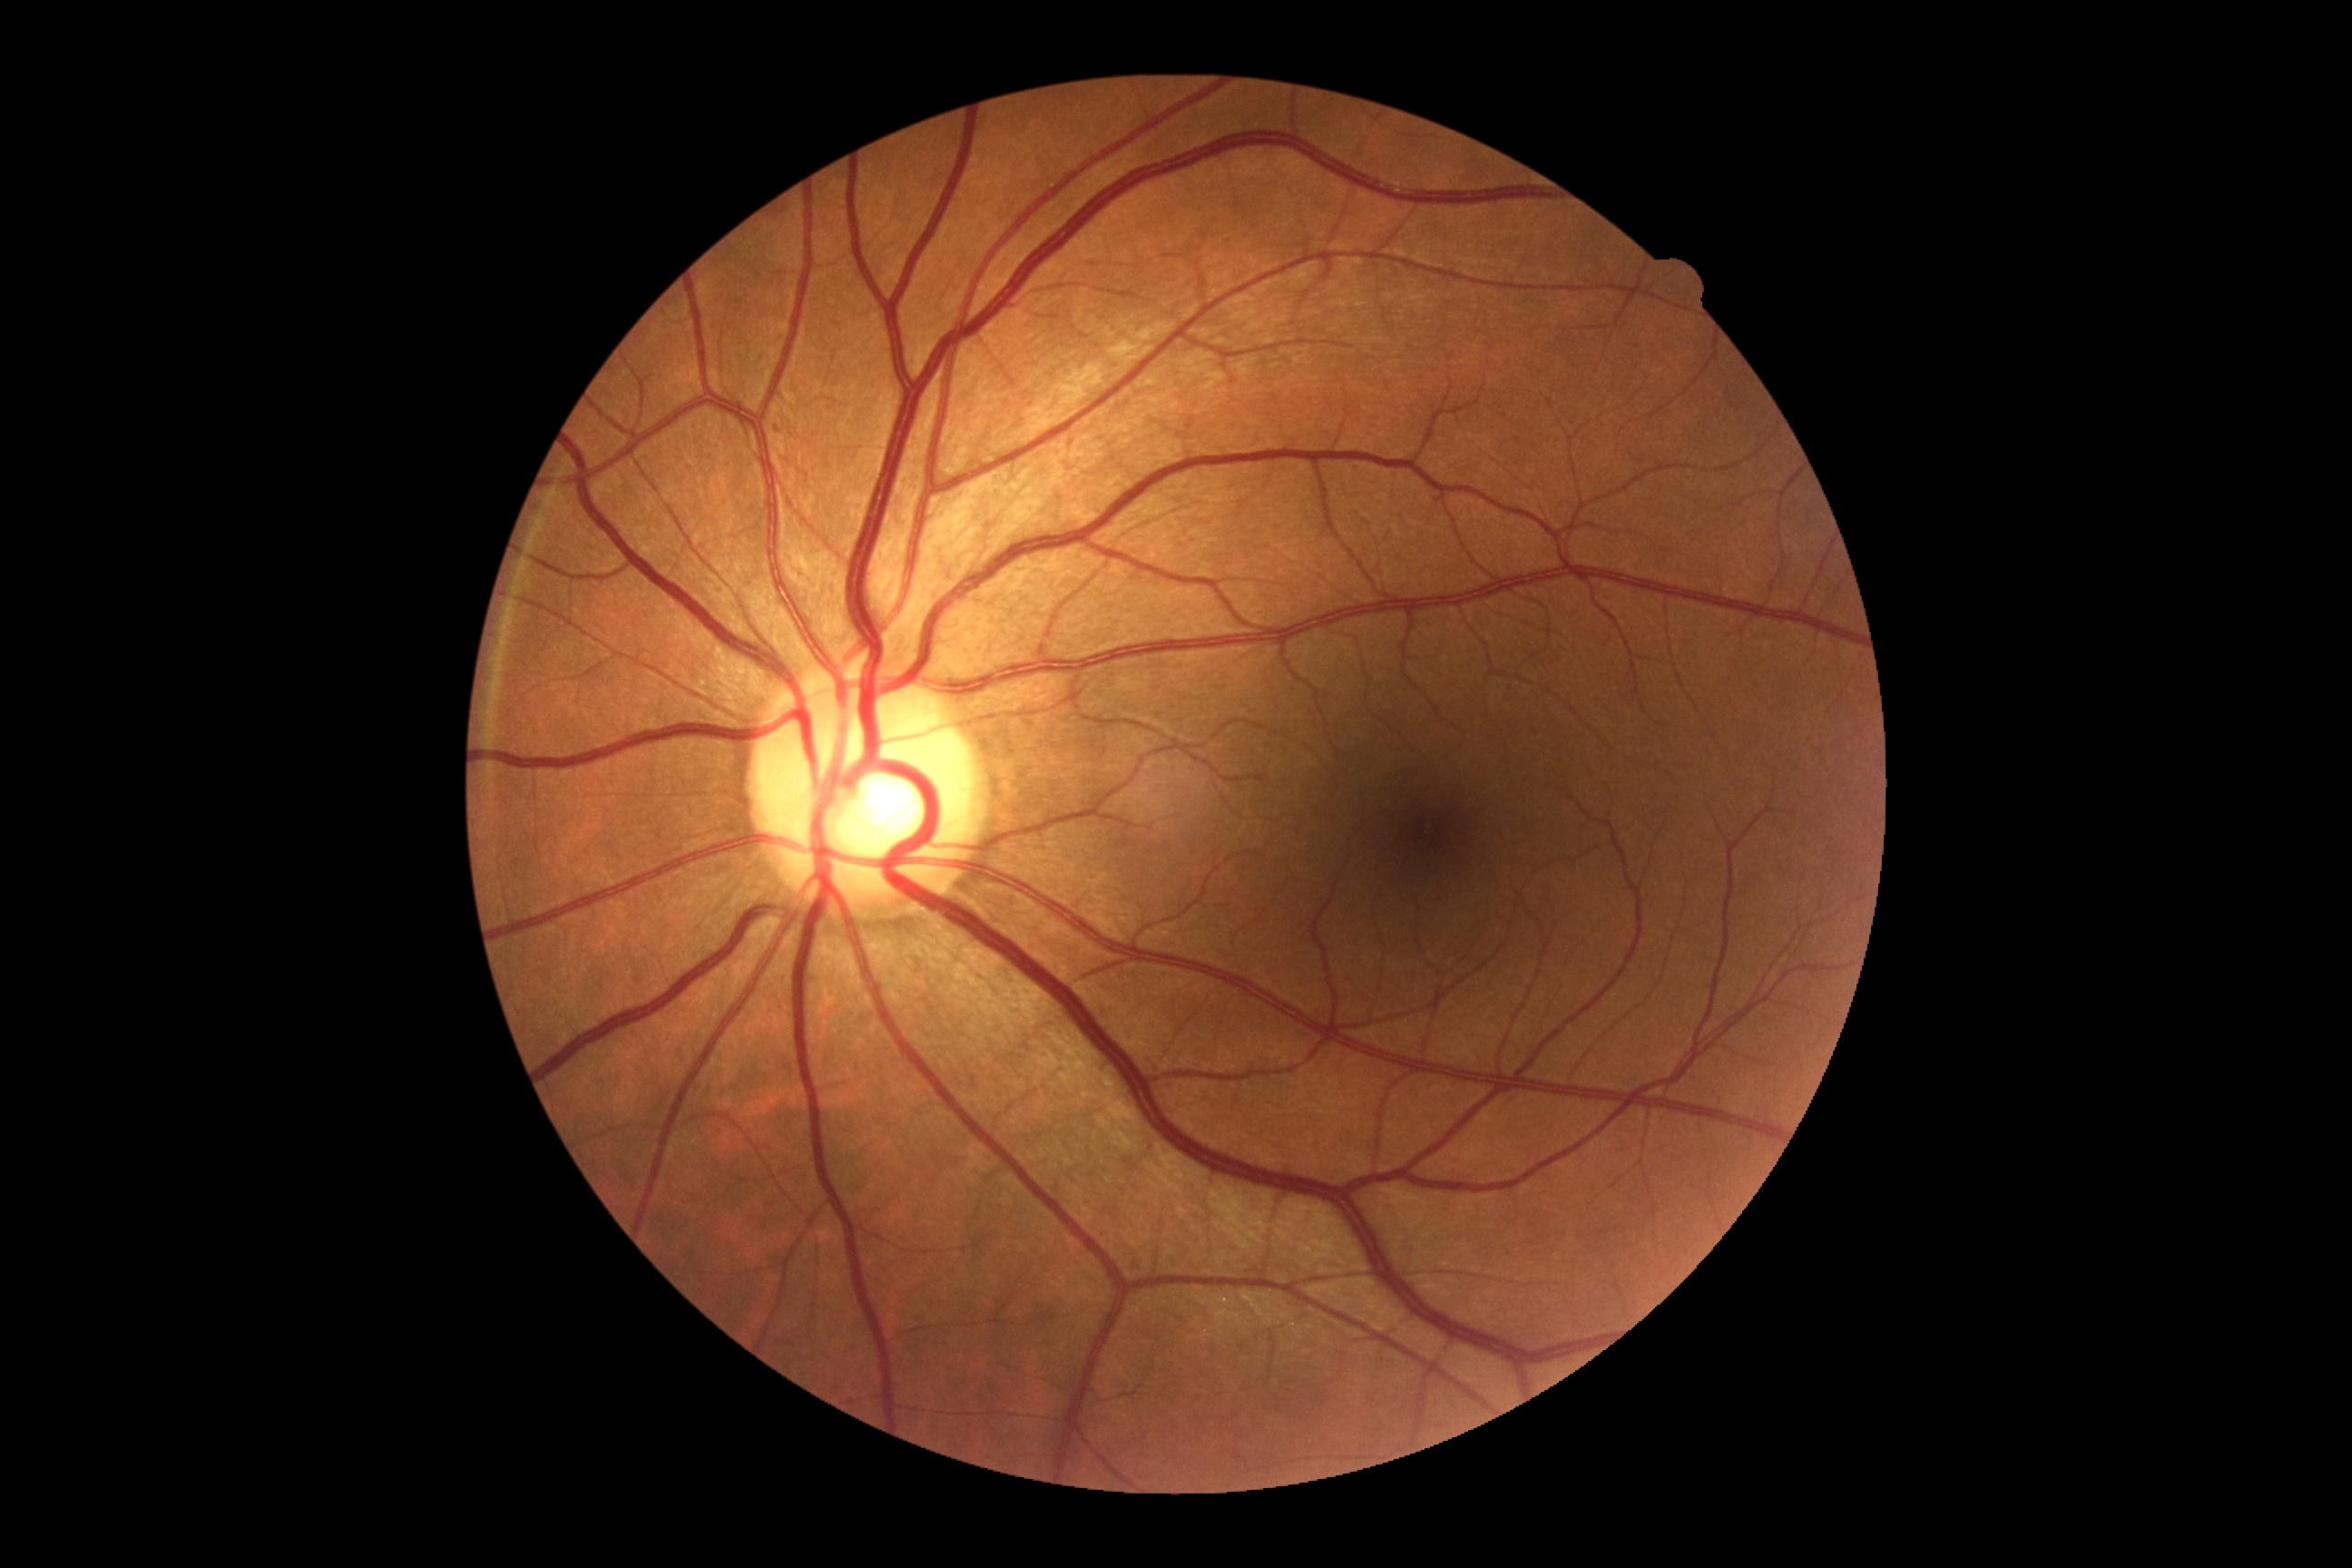 Diabetic retinopathy: 0.